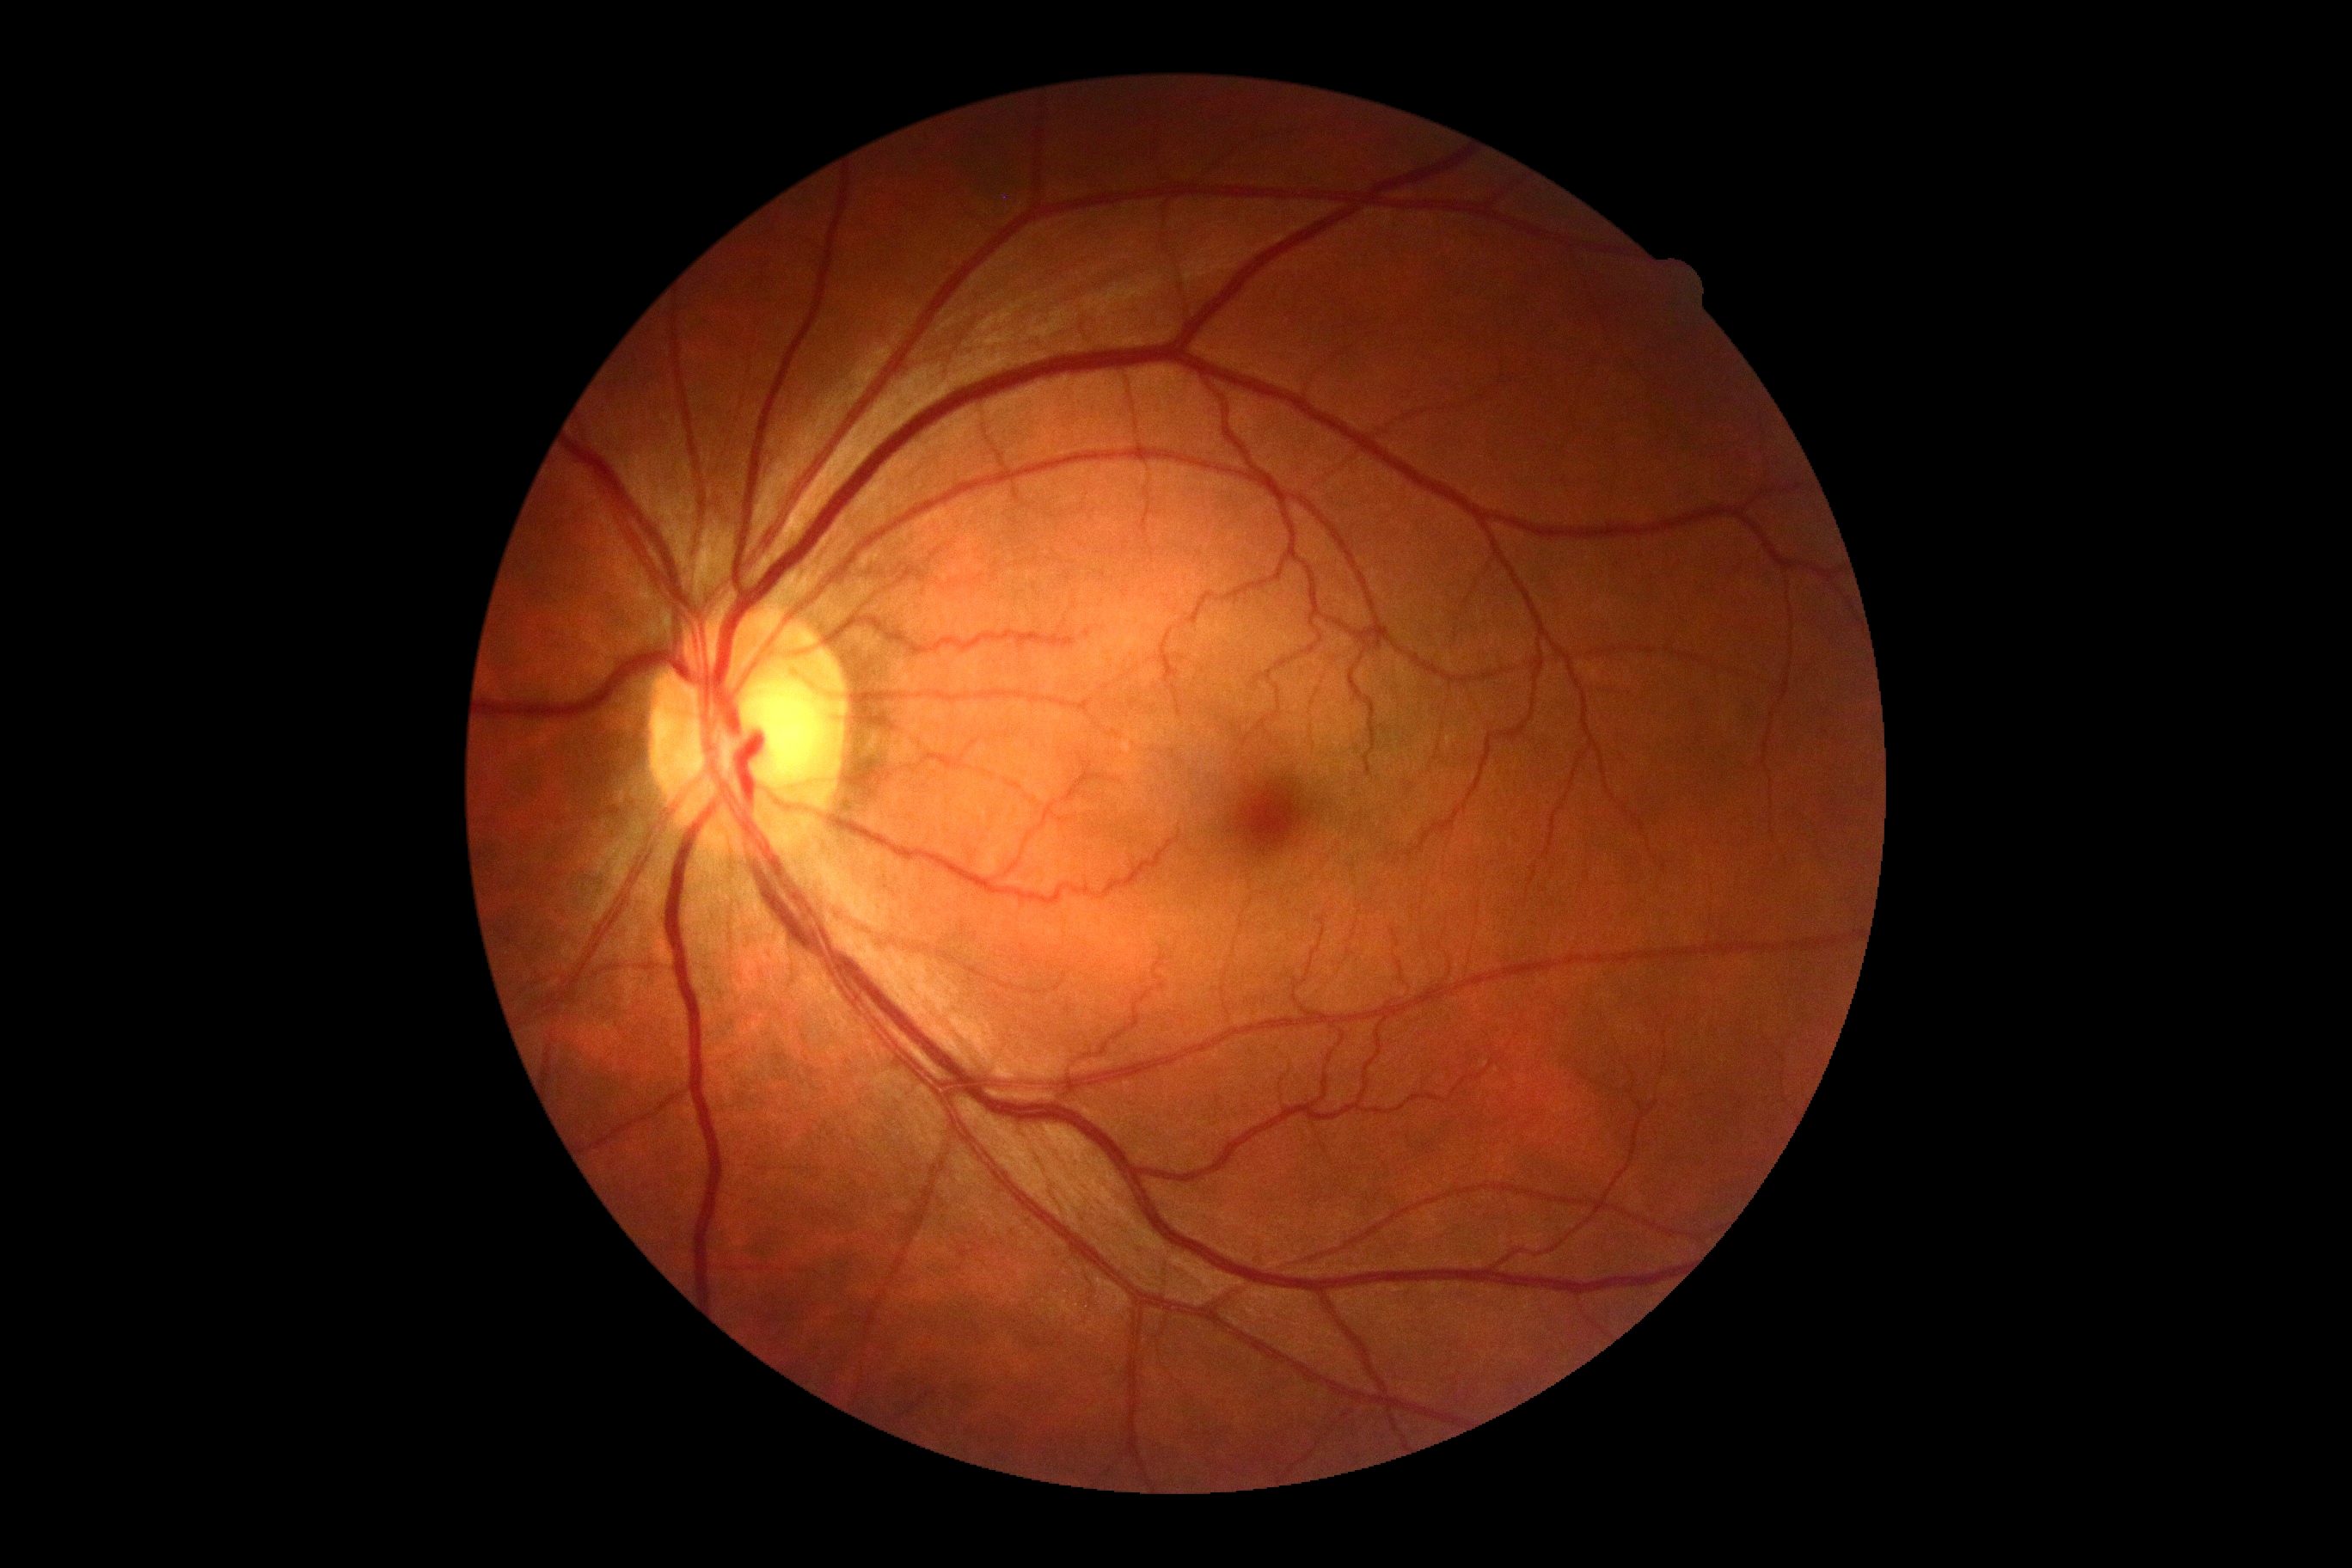
{"dr_grade": "0"}